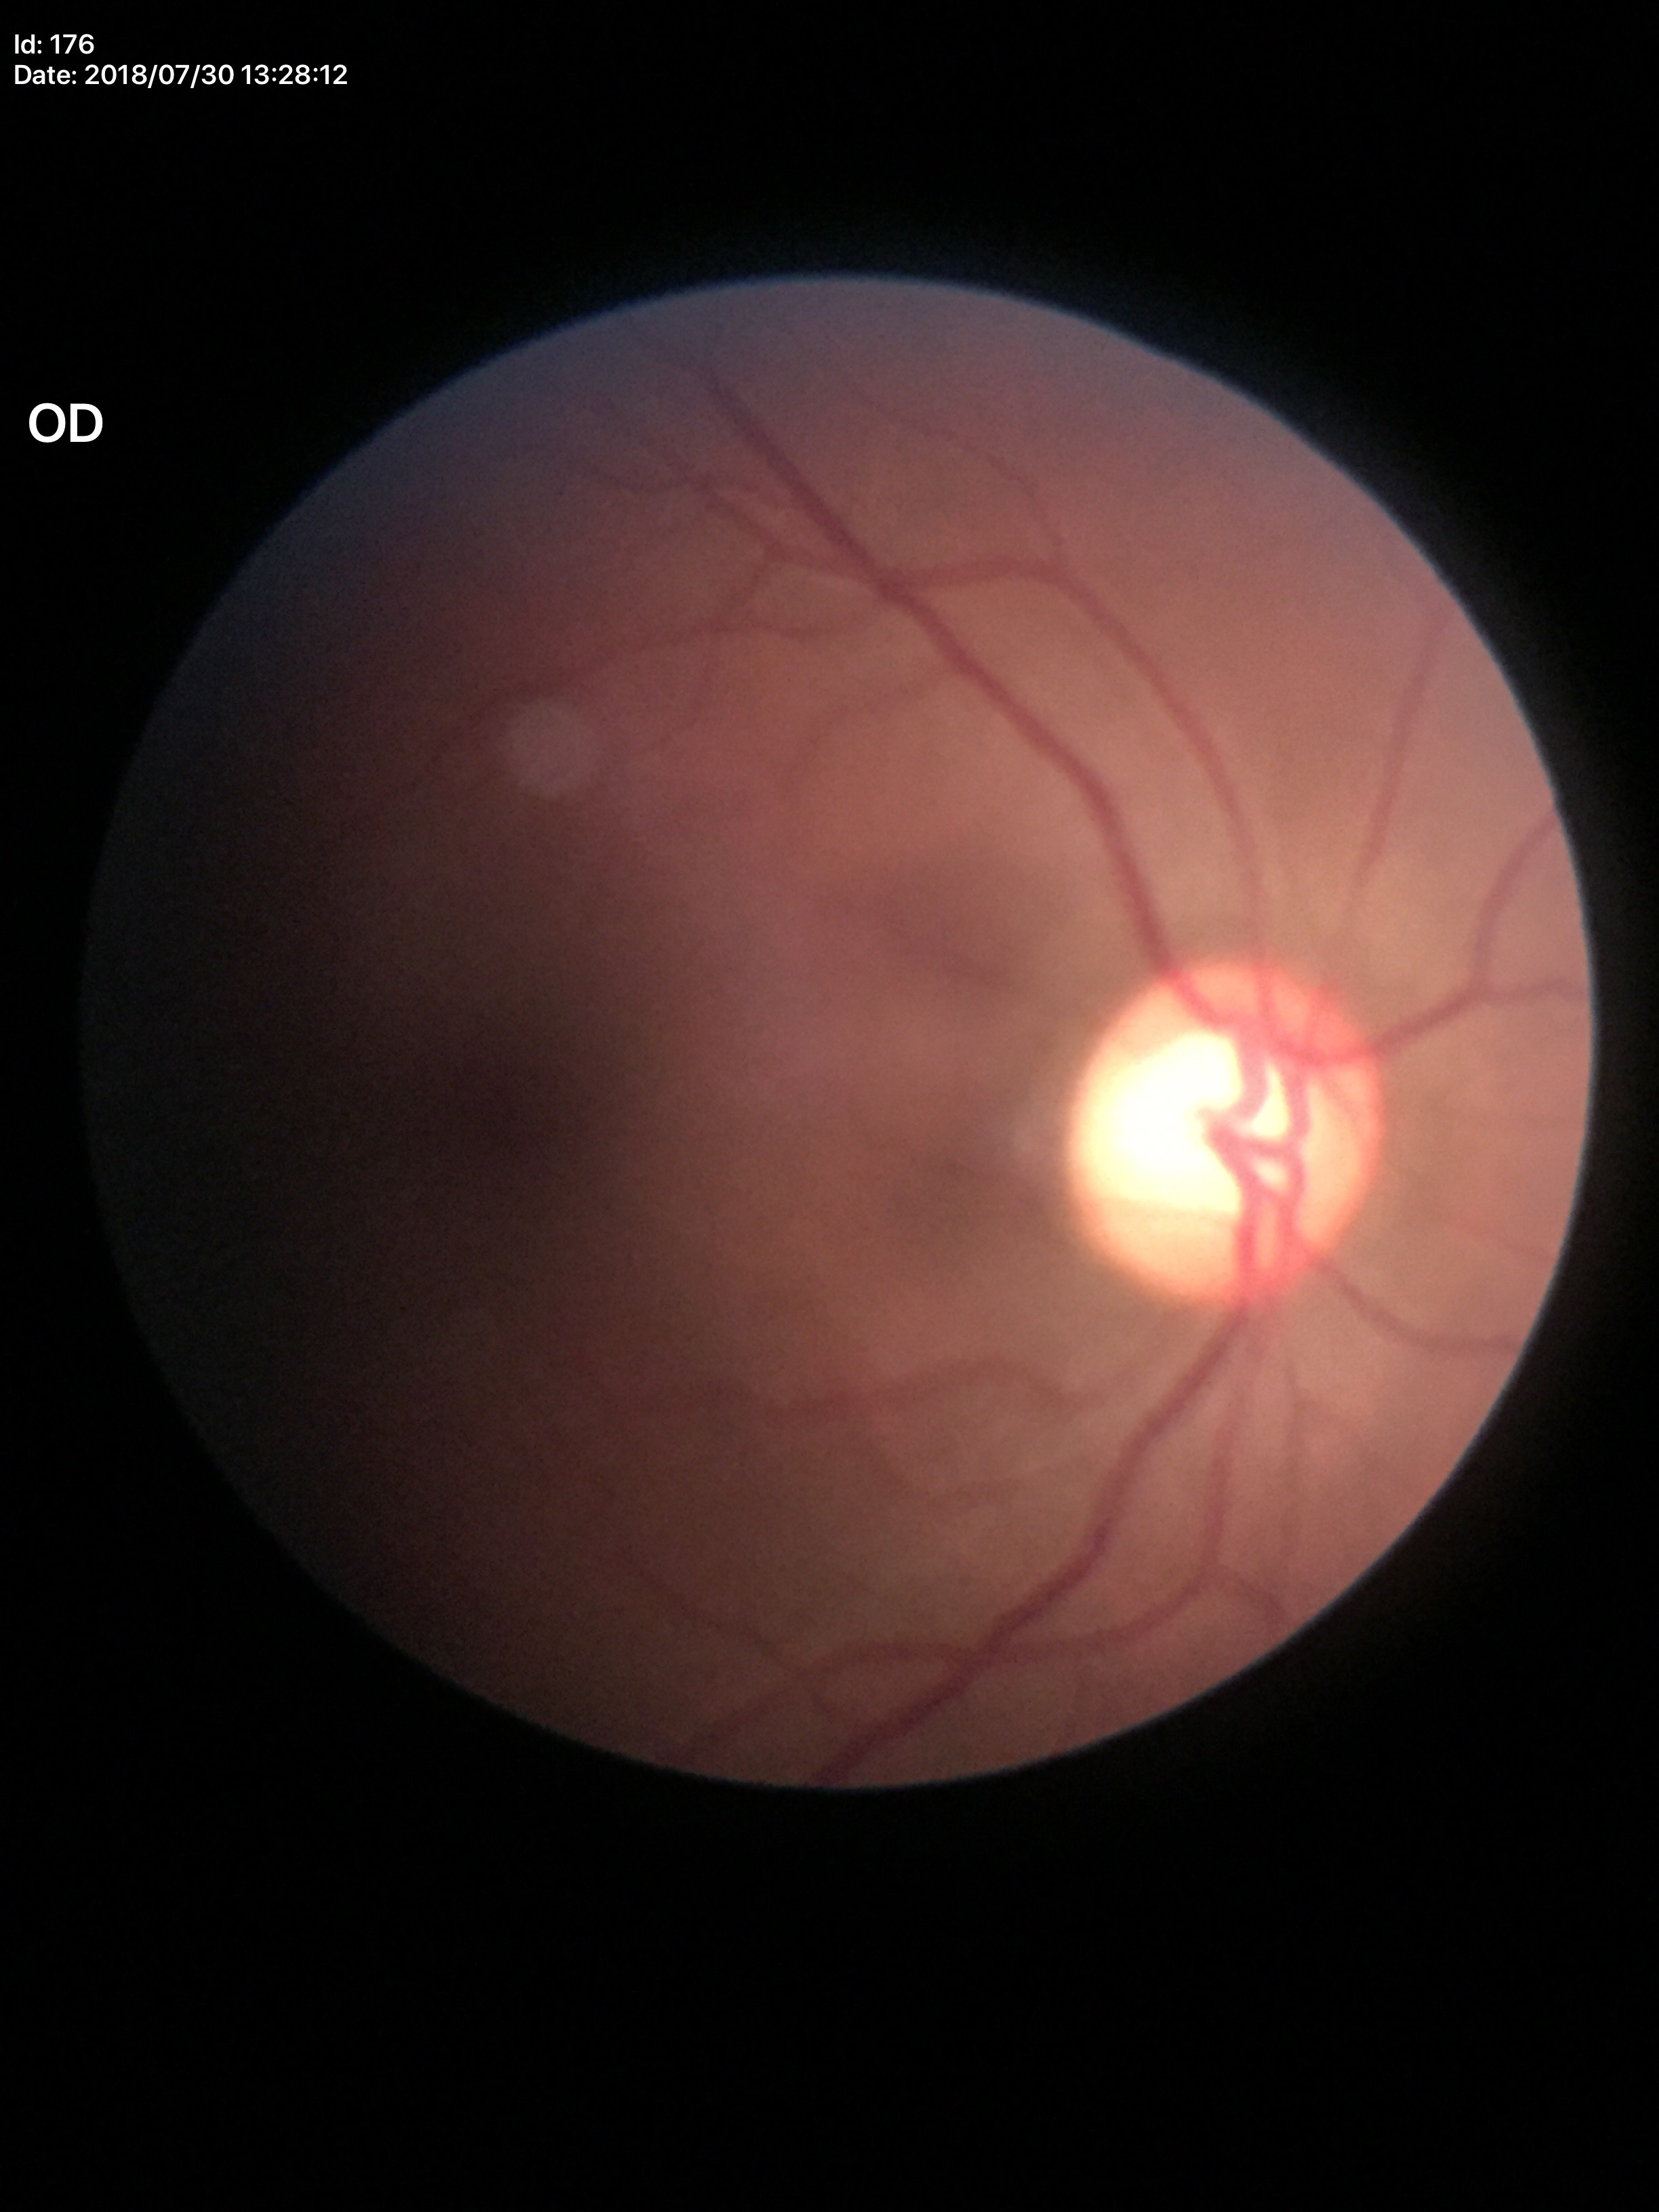

Glaucoma screening: not suspect (one of five ophthalmologists flagged glaucoma suspect) | VCDR: 0.59